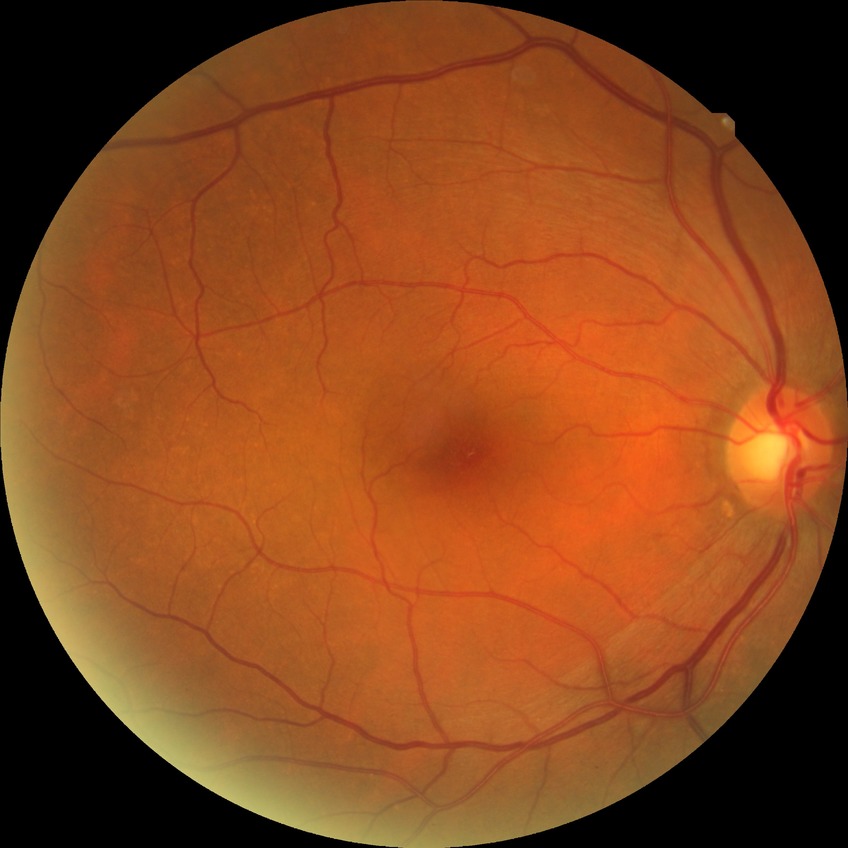
Assessment:
• retinopathy stage — no diabetic retinopathy